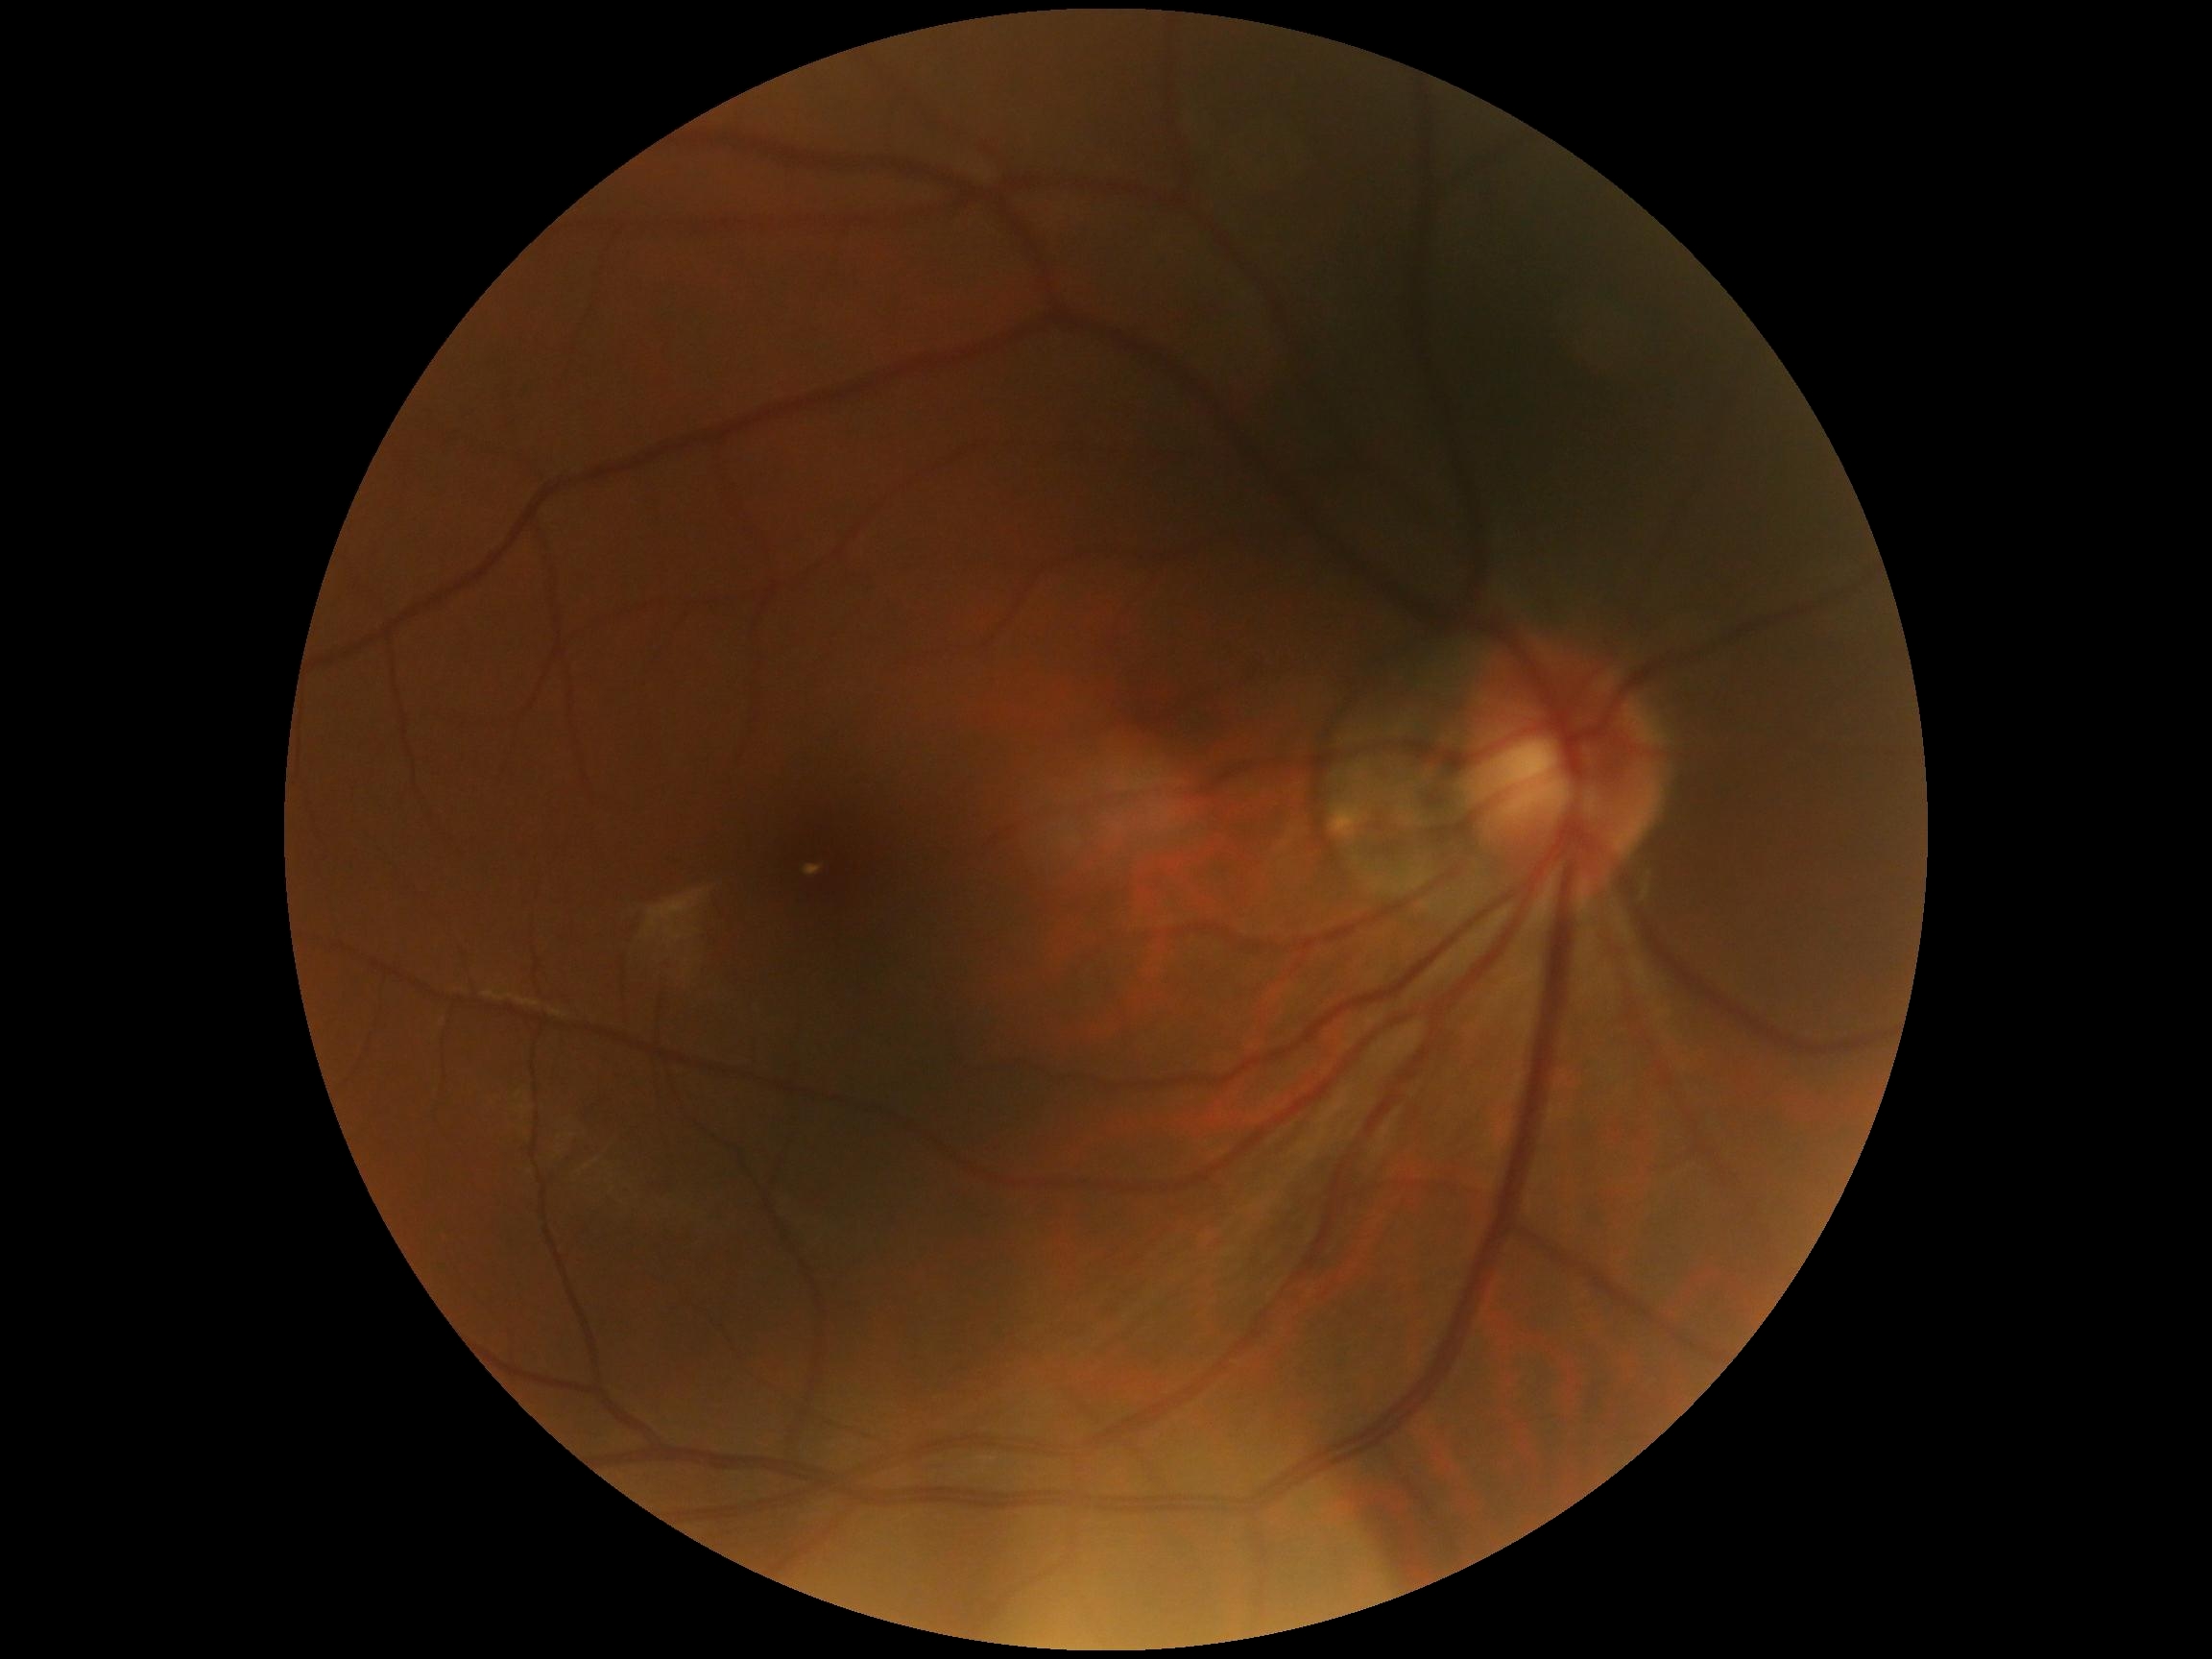
Diabetic retinopathy (DR) is grade 0 (no apparent retinopathy).
No DR findings.